Retinal fundus photograph.
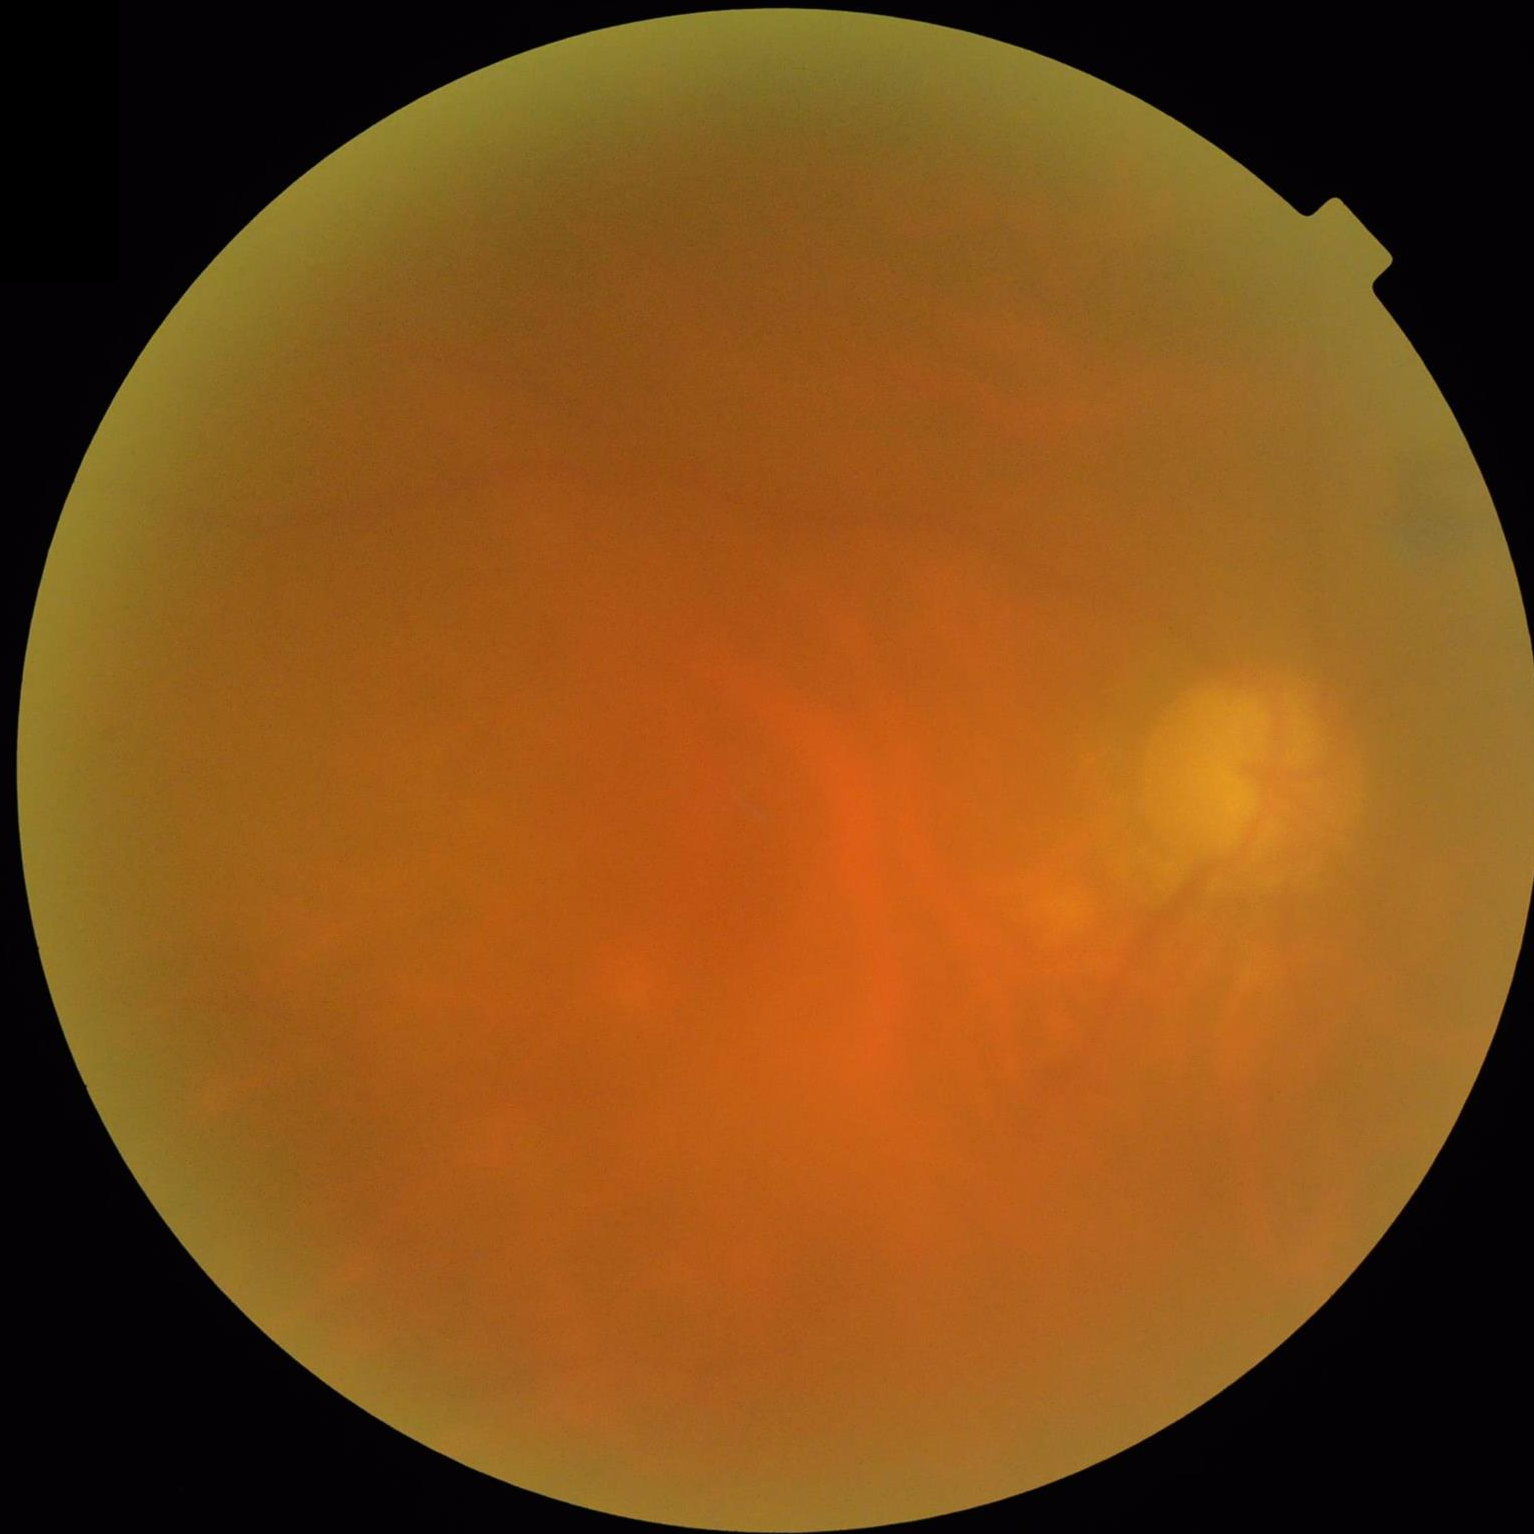 Quality assessment:
- illumination: over- or under-exposed
- focus: noticeable blur in the optic disc, vessels, or background
- overall: poor and difficult to use diagnostically
- contrast: poor dynamic range